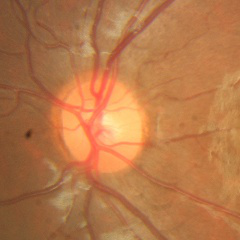
Optic disc photograph demonstrating no evidence of glaucoma.